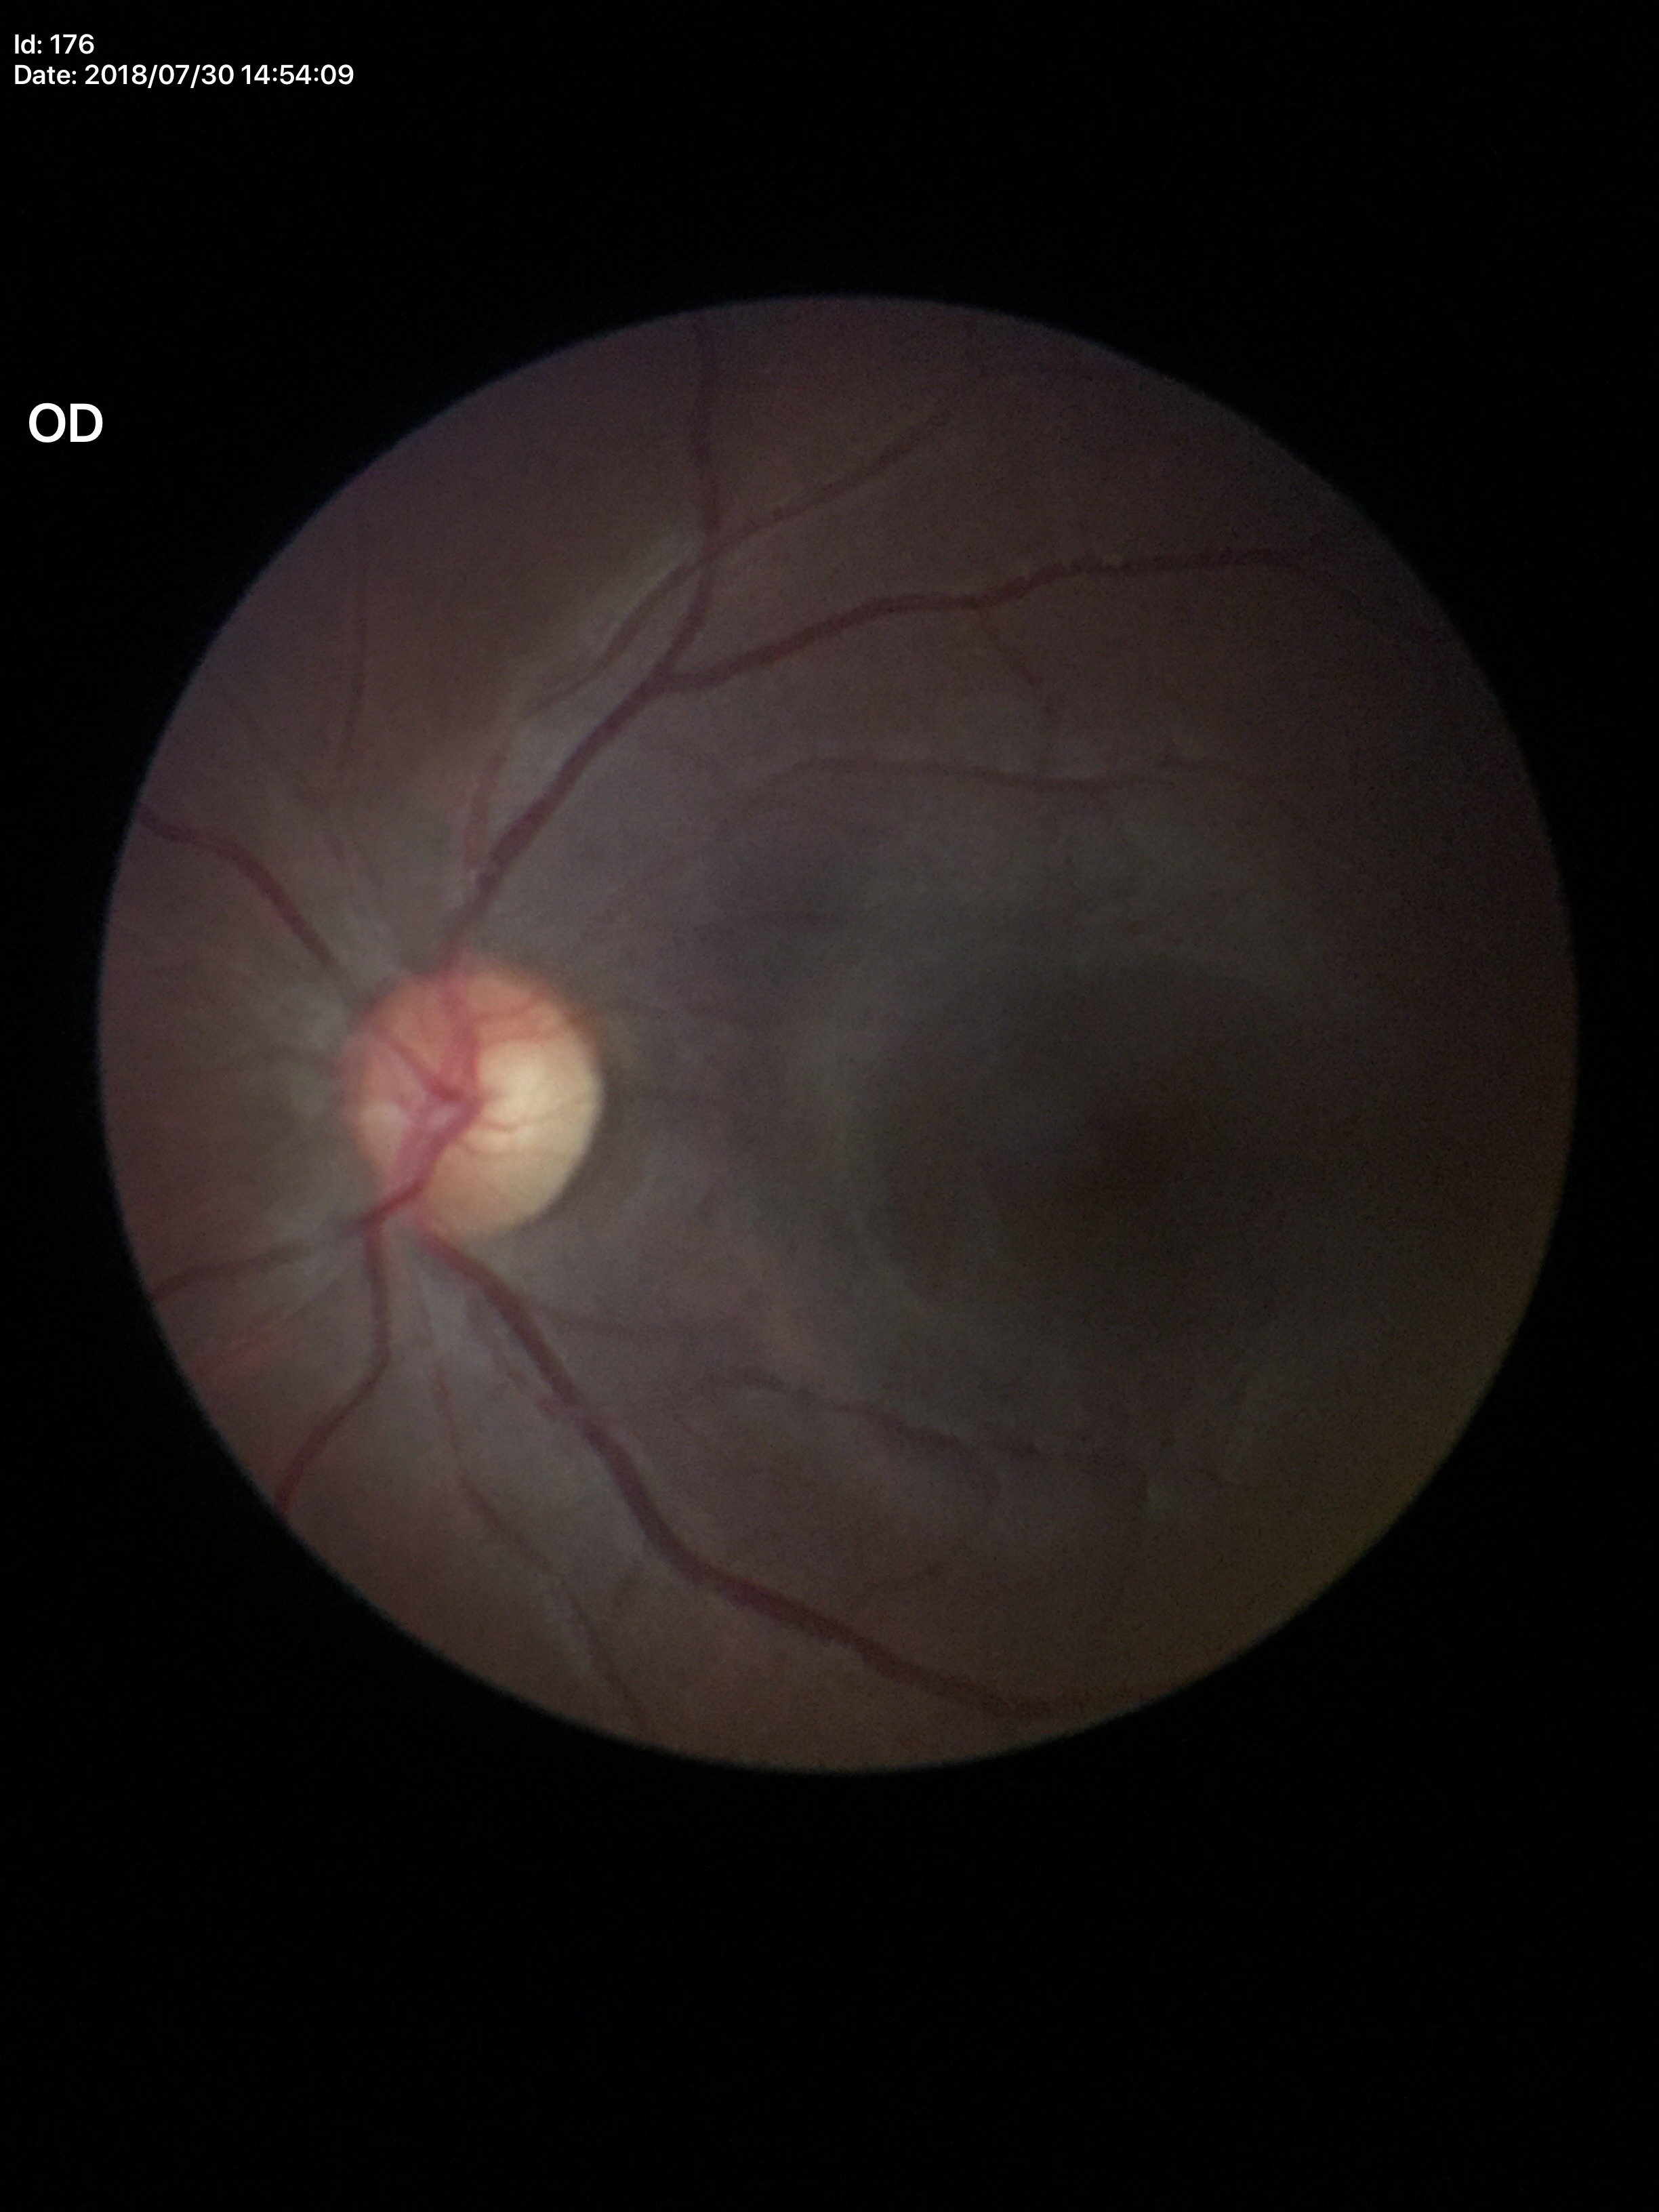

Glaucoma evaluation = no suspicious findings (1 of 5 graders flagged glaucoma suspect), vertical C/D ratio (VCDR) = 0.54.